1440x1080 · RetCam wide-field infant fundus image — 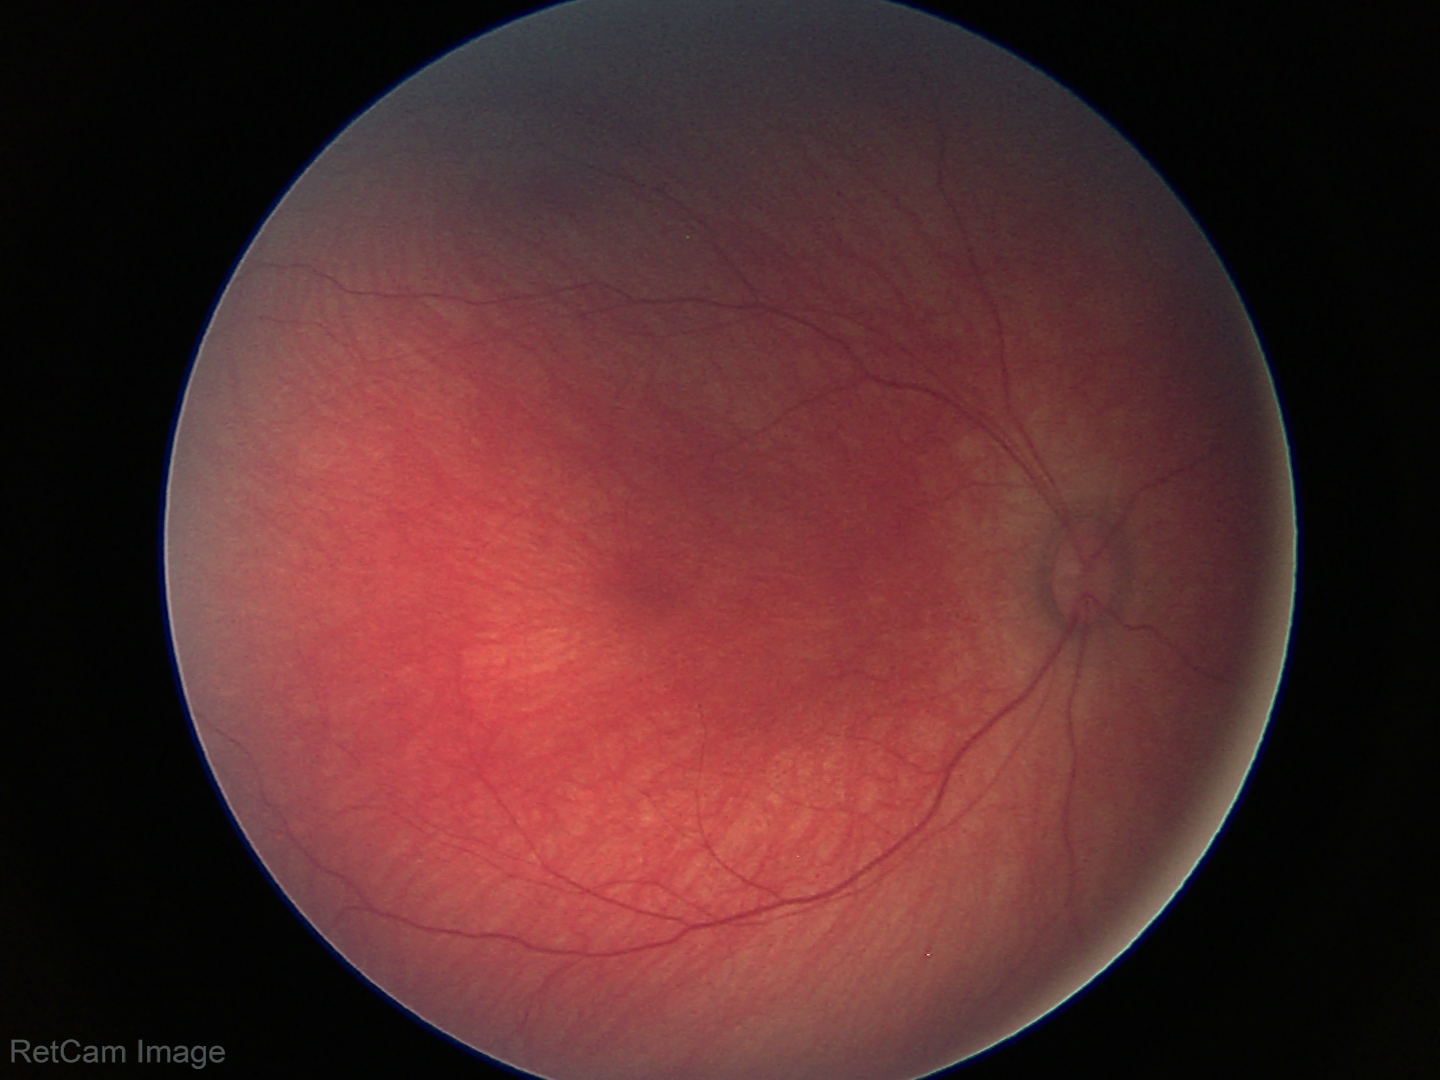 Screening: physiological retinal finding.